640 x 480 pixels; captured with the Clarity RetCam 3 (130° field of view); wide-field fundus image from infant ROP screening.
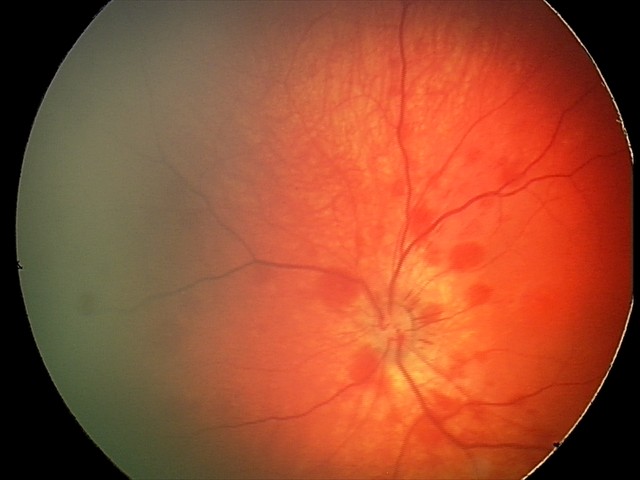 Screening examination consistent with retinal hemorrhages.